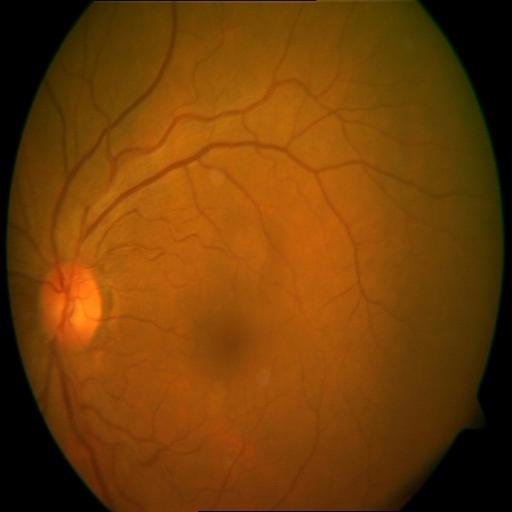

Diagnoses: CME (cystoid macular edema).